Nonmydriatic fundus photograph; 848x848; fundus photo; NIDEK AFC-230 fundus camera; 45-degree field of view.
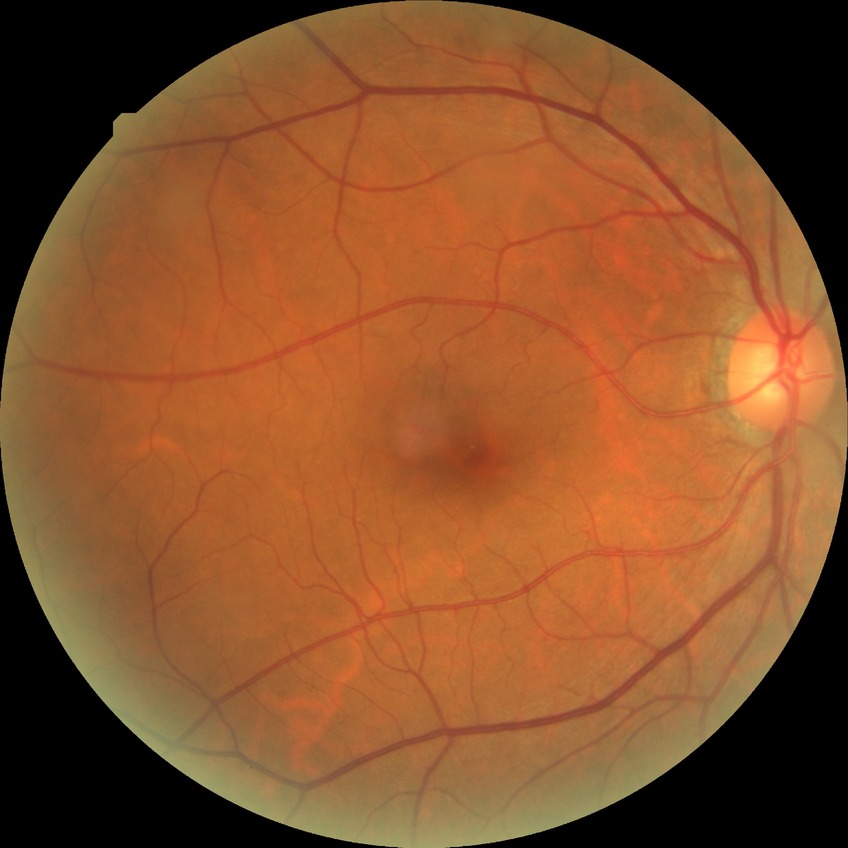
Diabetic retinopathy severity is simple diabetic retinopathy. DR class: non-proliferative diabetic retinopathy.